848 by 848 pixels; nonmydriatic; color fundus image; modified Davis classification
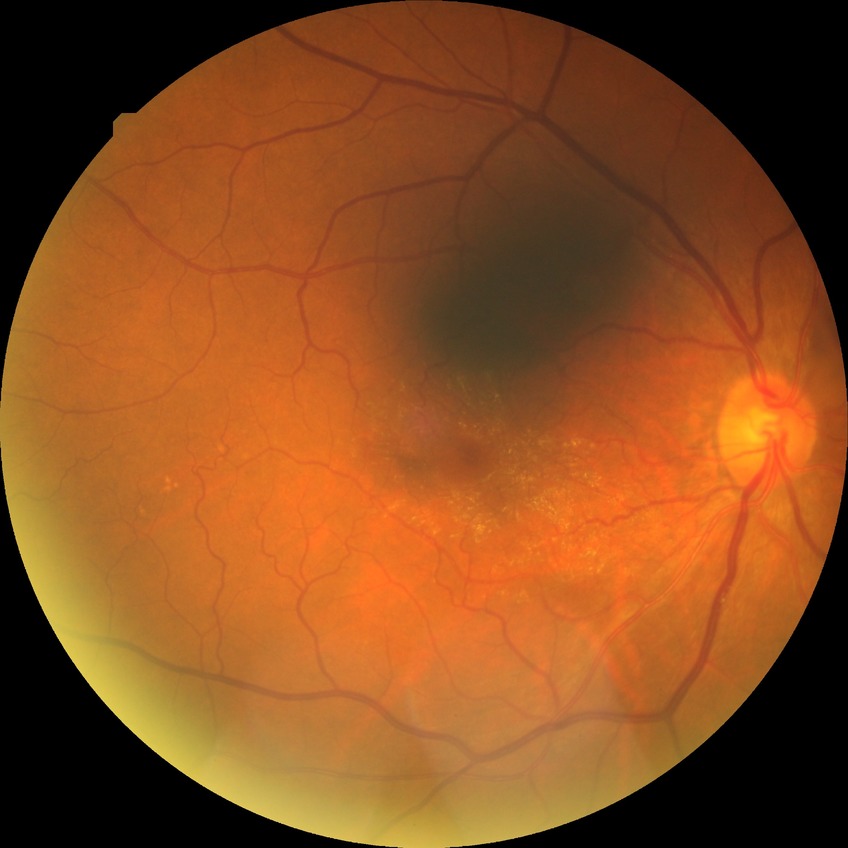 retinopathy grade@no diabetic retinopathy.